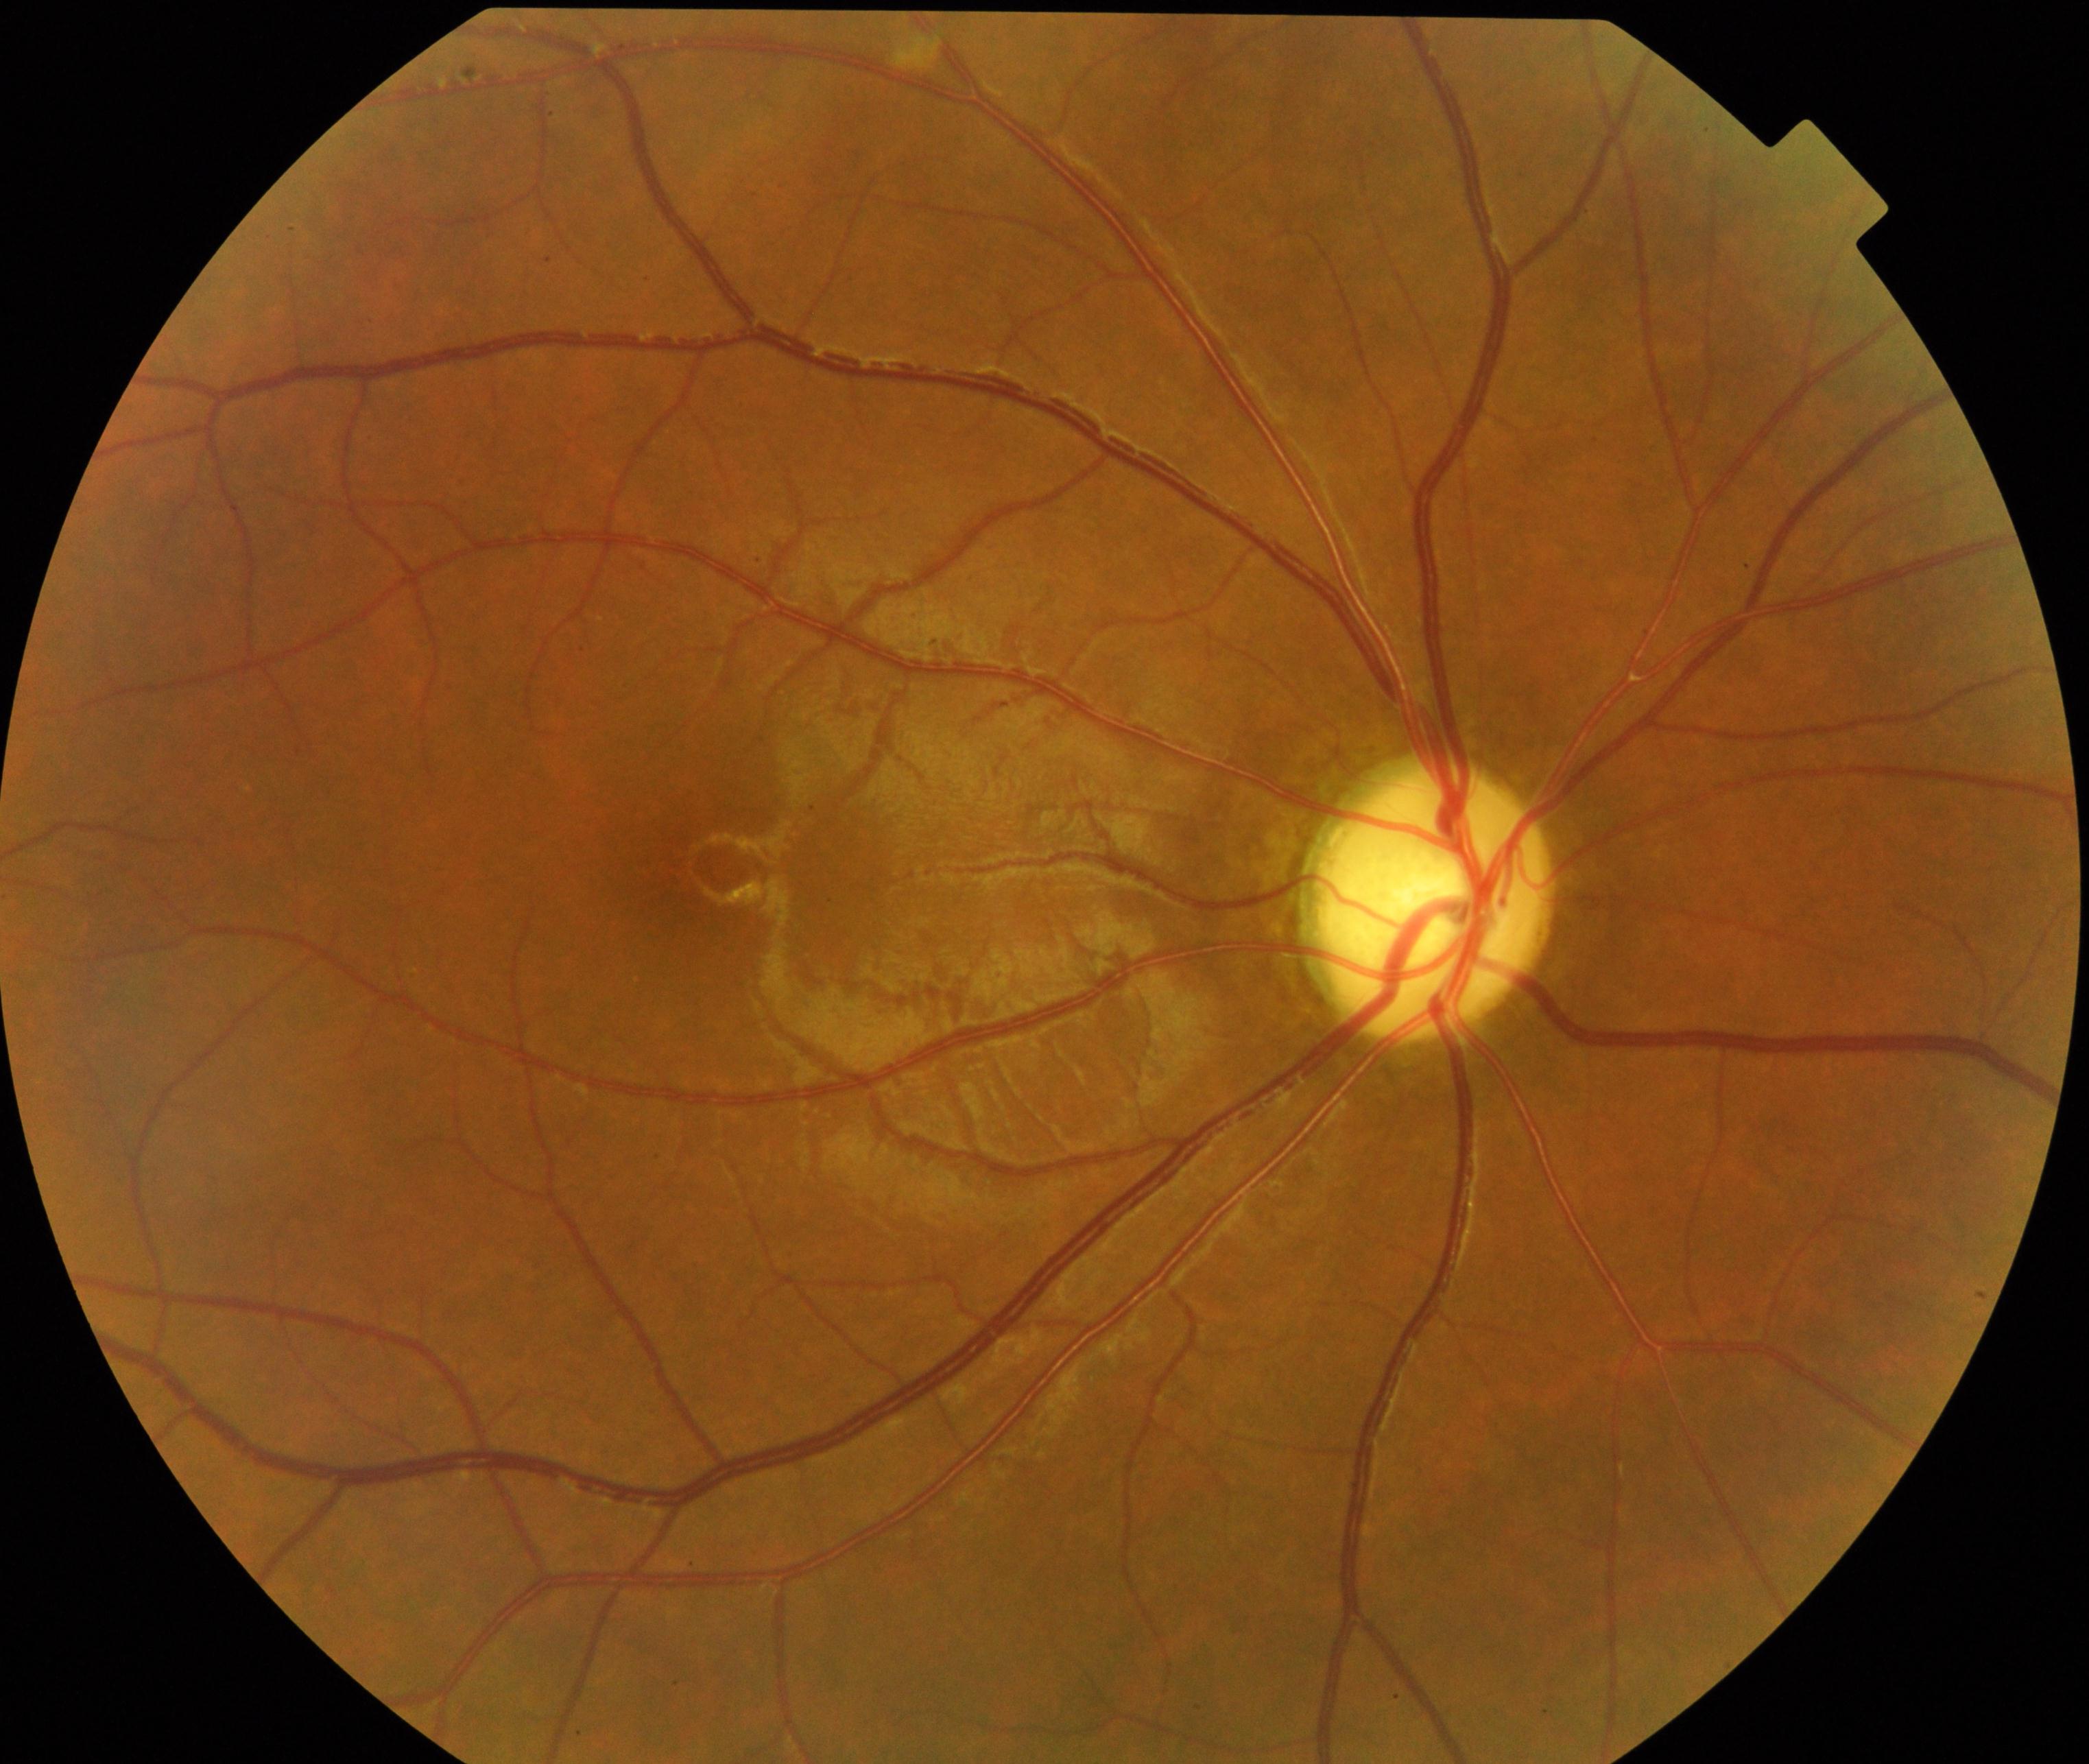 Classification: optic atrophy.